Acquired on the Clarity RetCam 3 · image size 640x480 · infant wide-field fundus photograph:
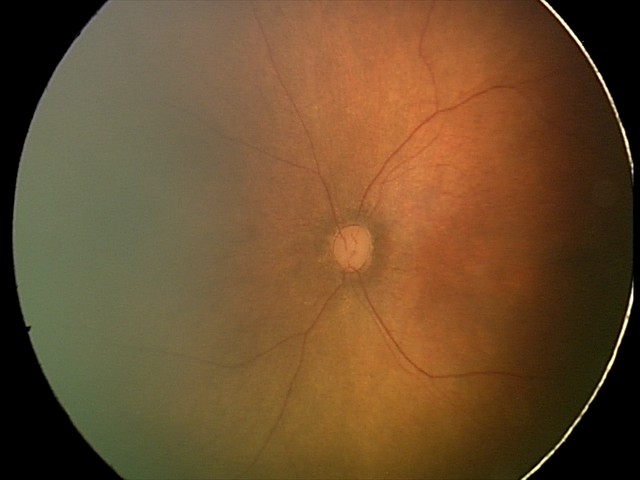

Normal screening examination.